Wide-field fundus photograph of an infant: 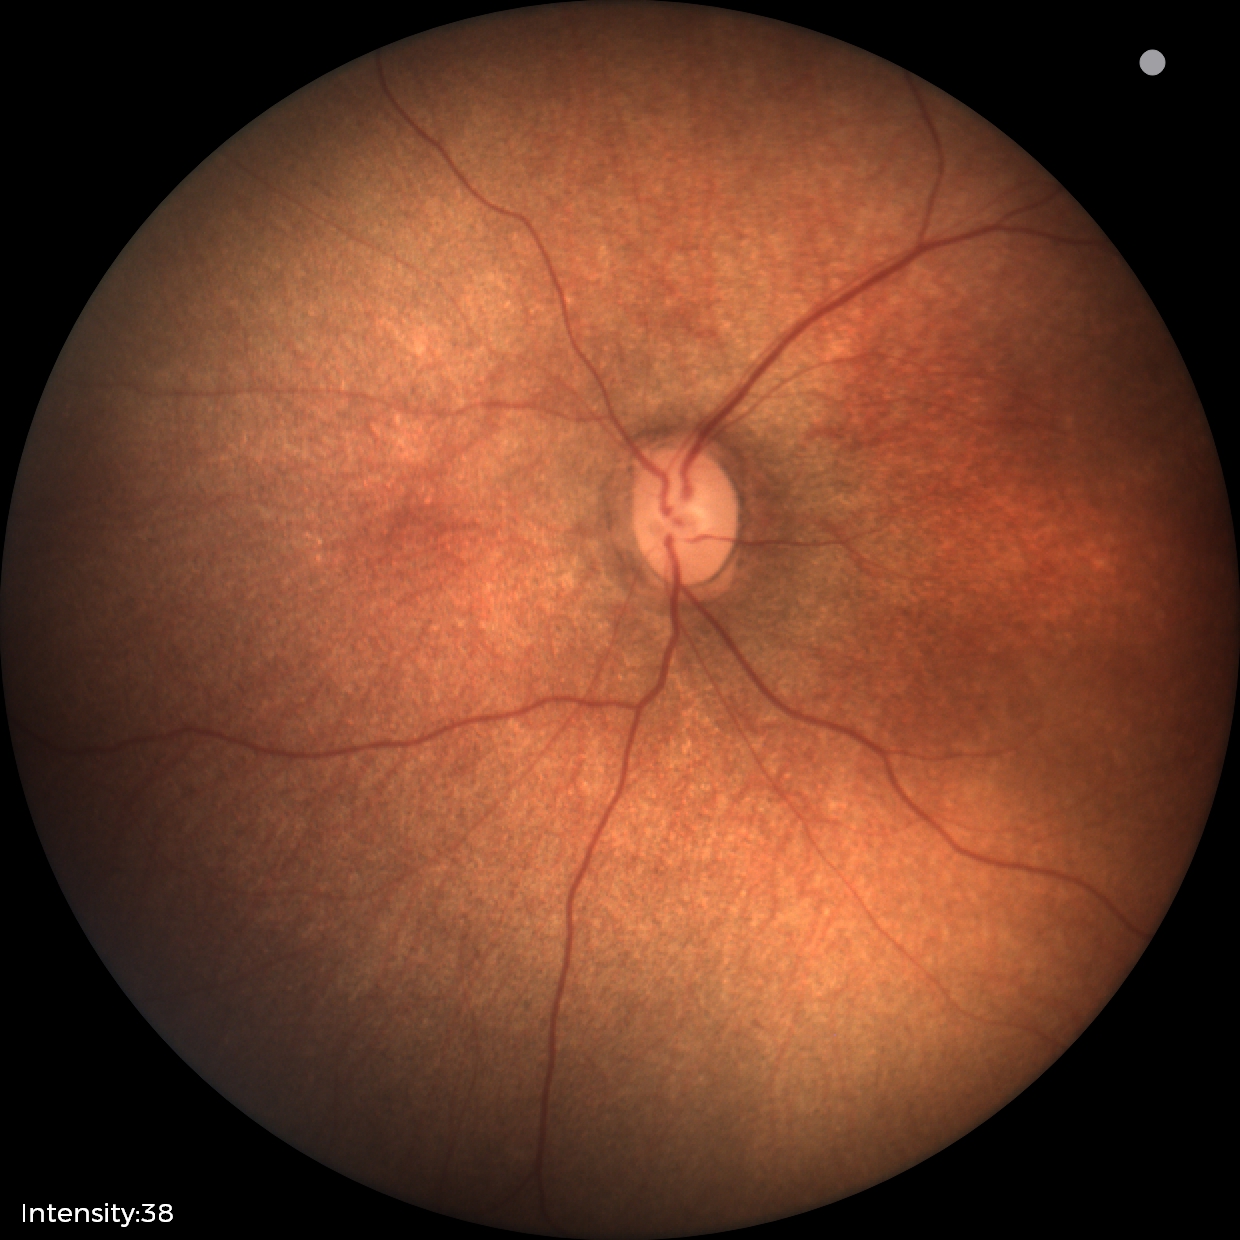
Screening examination with no abnormal retinal findings.